Image size 1472x1473 · 45-degree field of view · fundus photo — 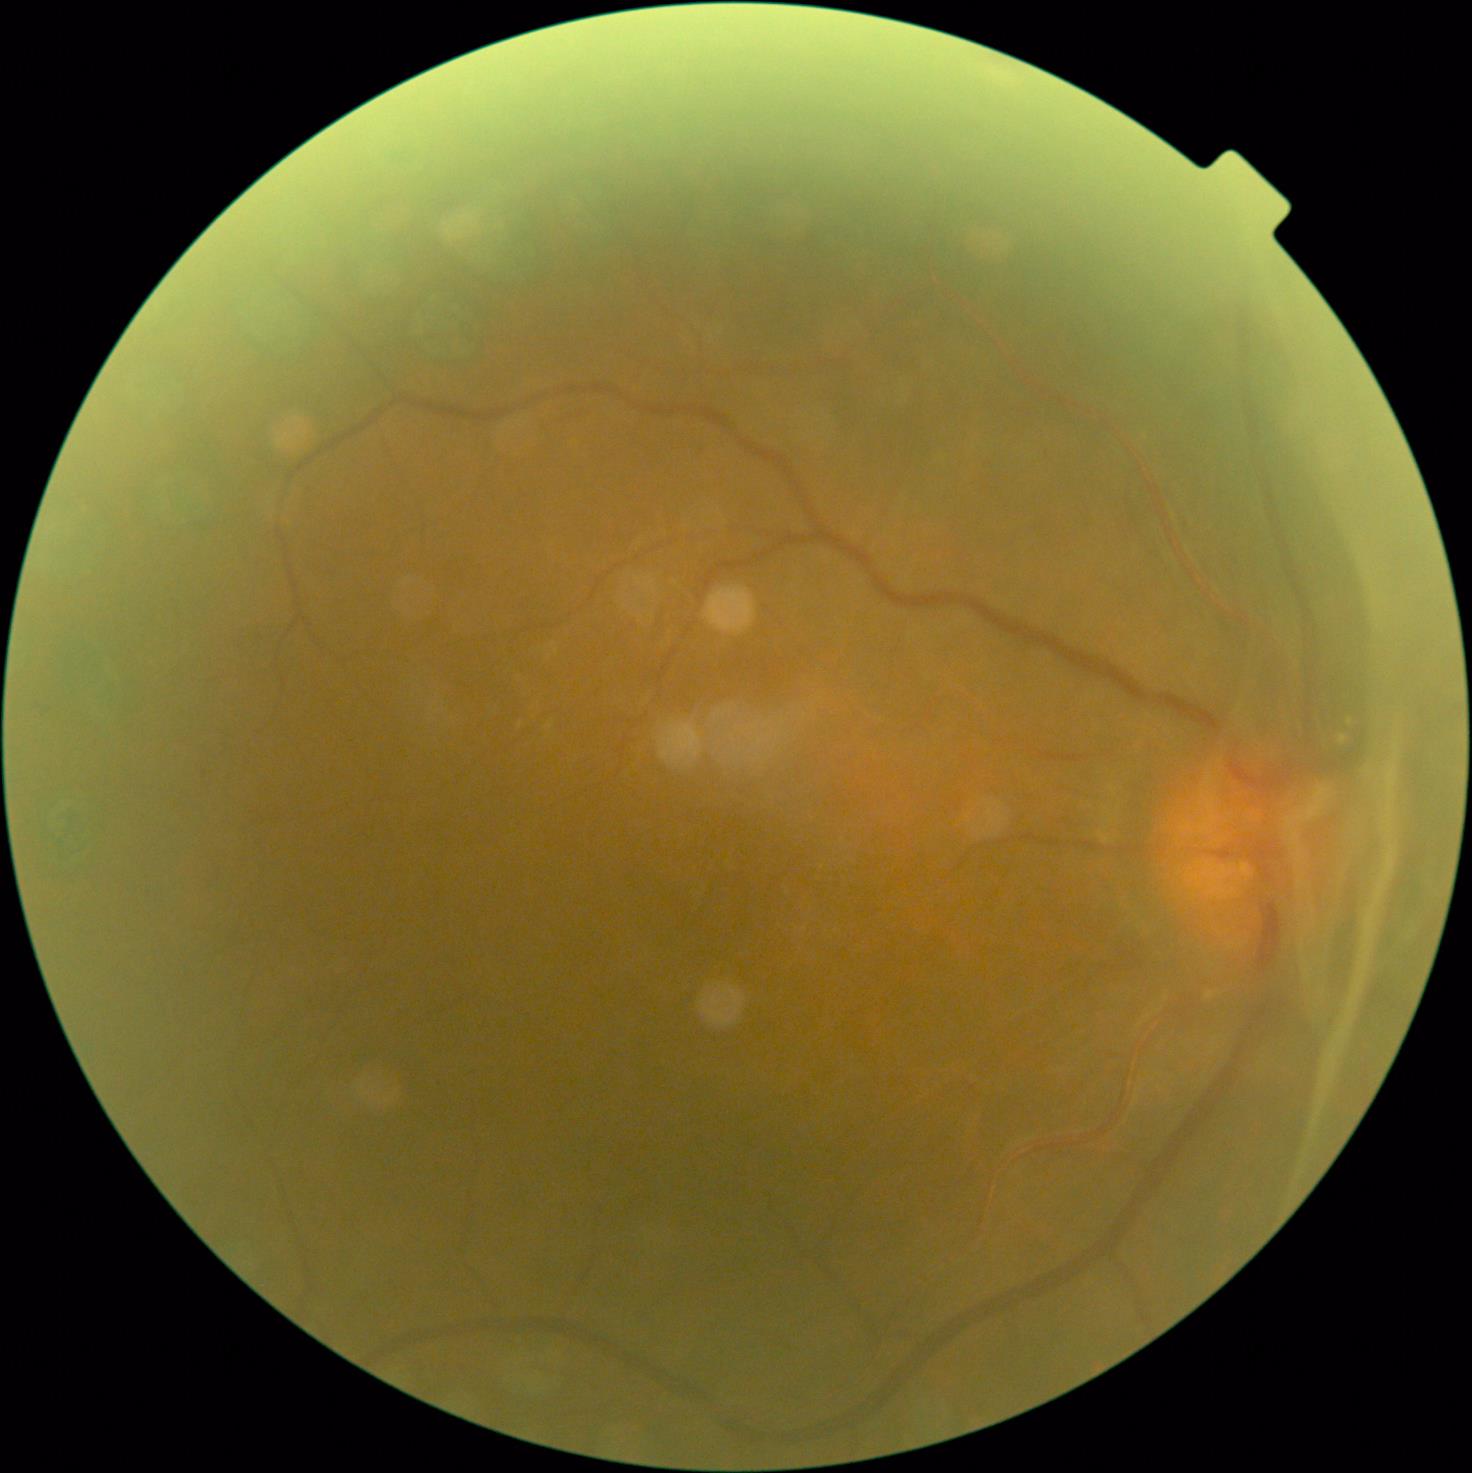
{"dr_grade": "grade 4 (PDR)"}